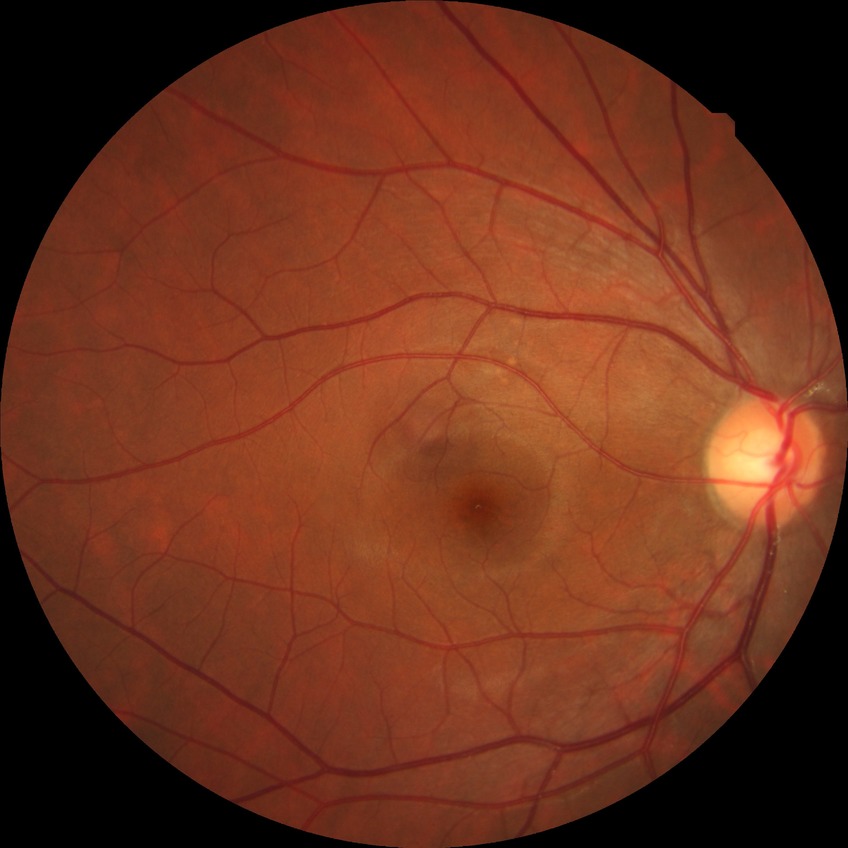
  davis_grade: NDR (no diabetic retinopathy)